Retinal fundus photograph, 45-degree field of view — 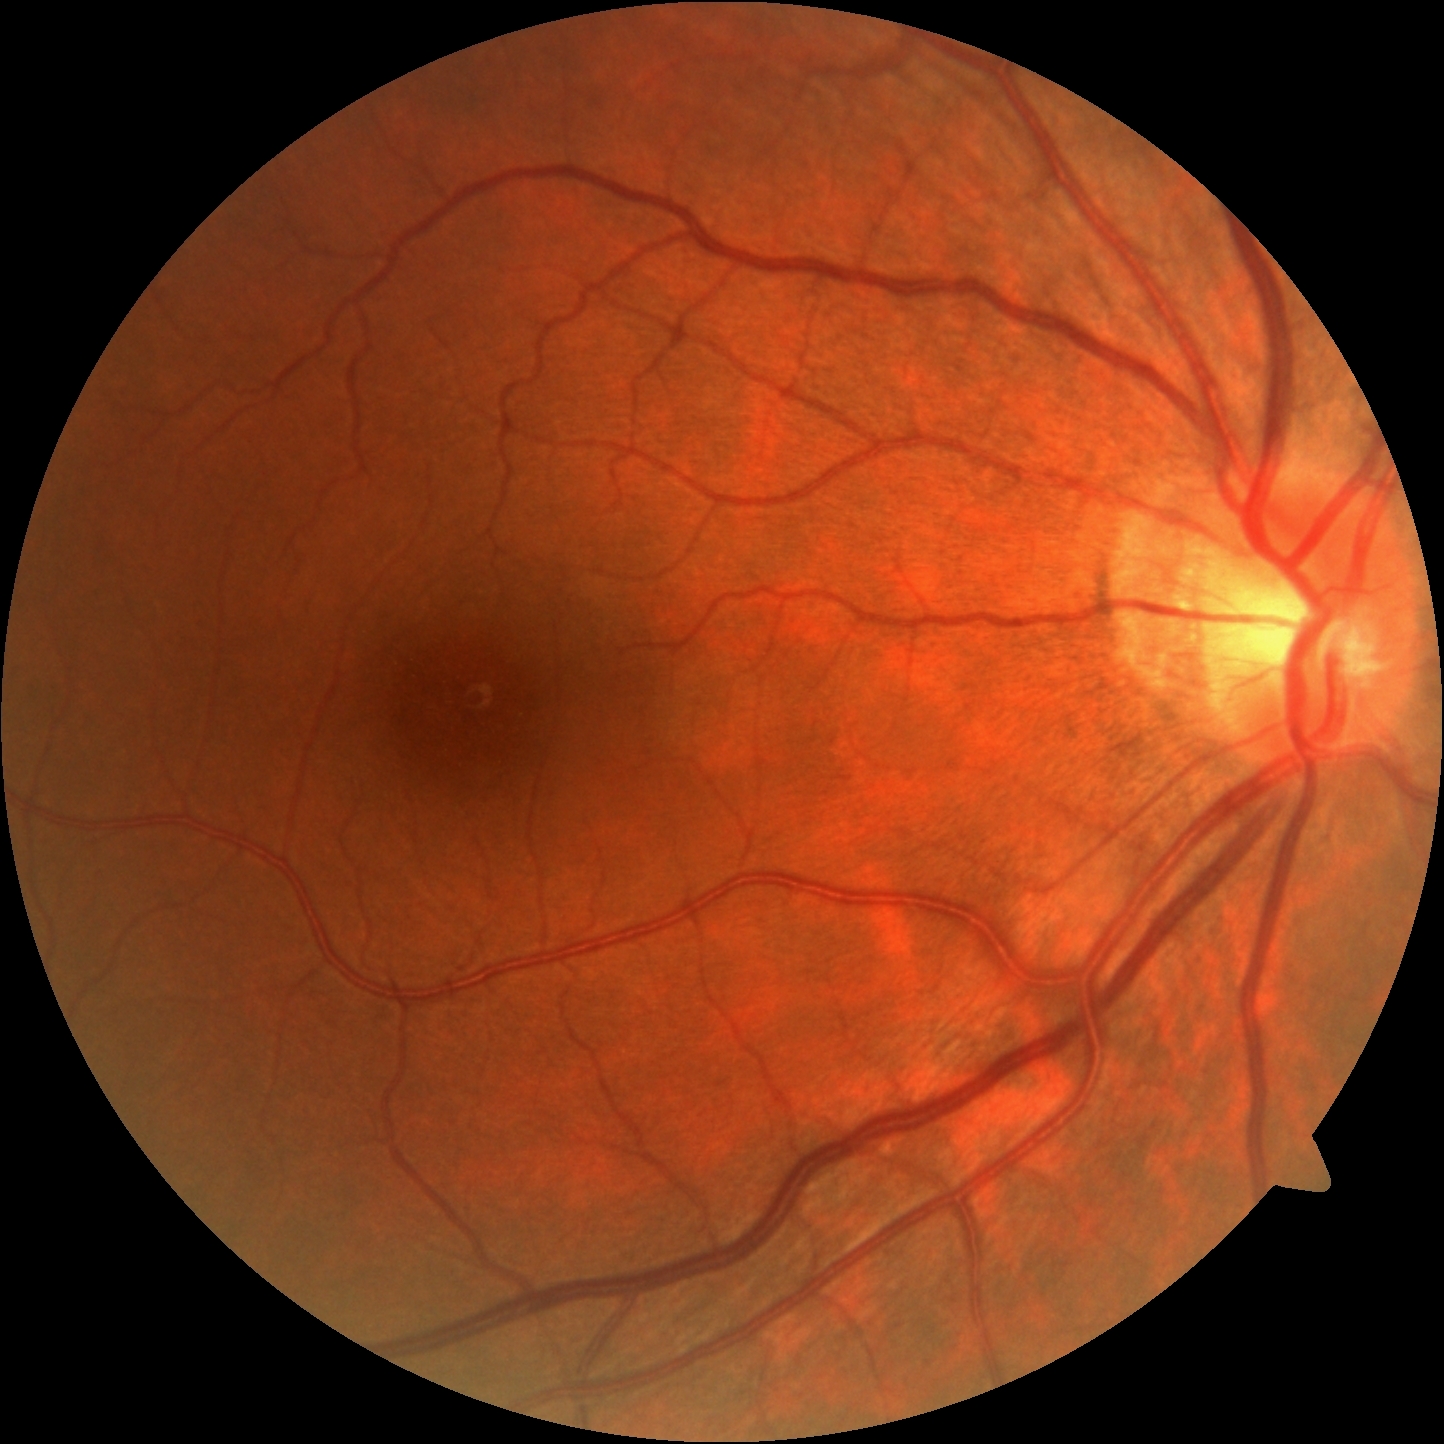
Annotations:
• retinopathy: grade 0 (no apparent retinopathy)
• DR impression: no apparent DR